848x848px; posterior pole photograph.
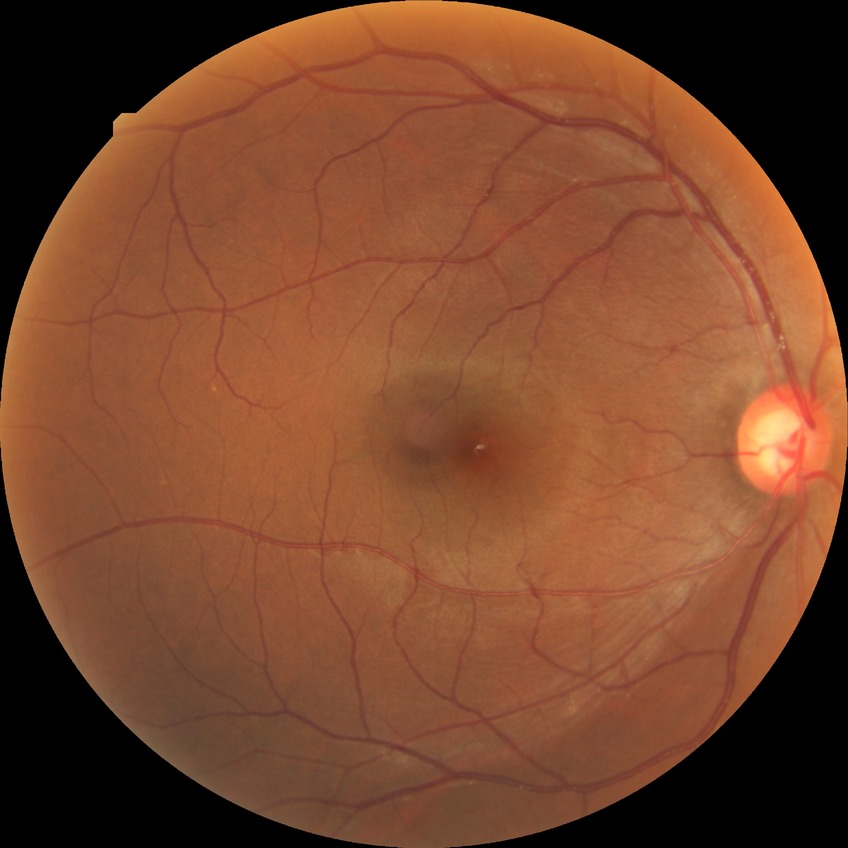
diabetic retinopathy (DR)=NDR (no diabetic retinopathy).